2352x1568px — 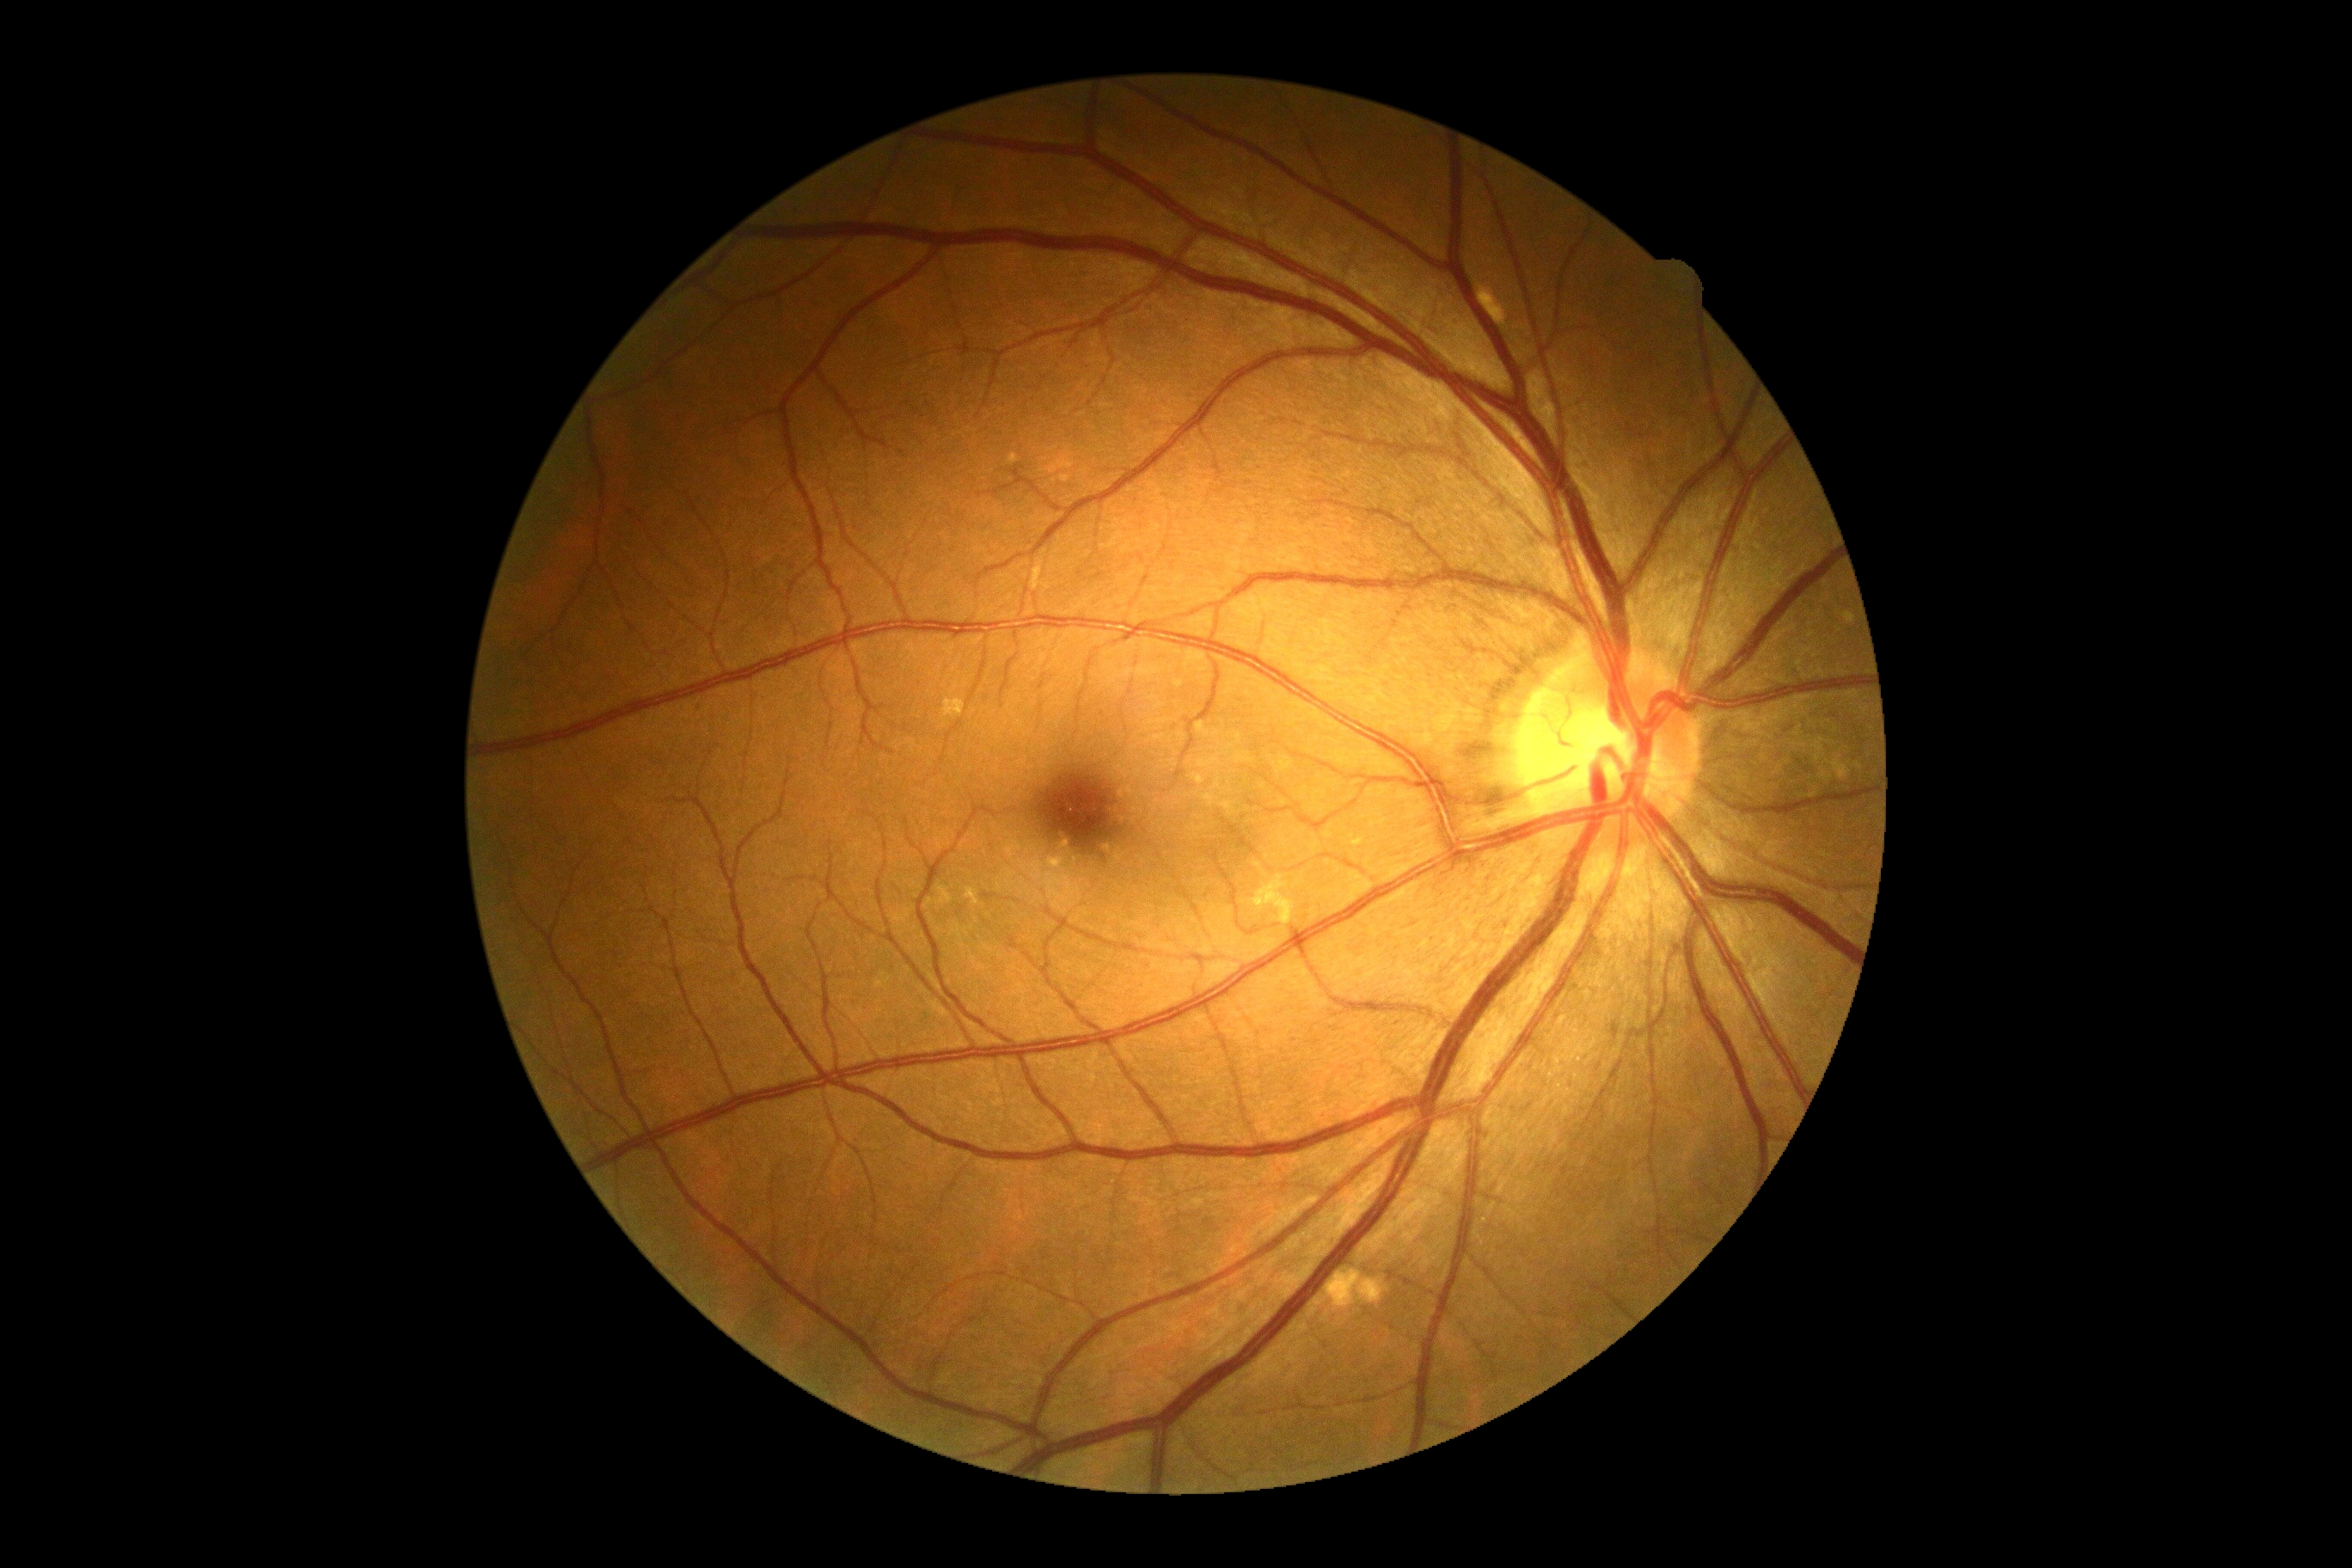

Diabetic retinopathy severity is grade 0 (no apparent retinopathy).